Image size 640x480; acquired on the Clarity RetCam 3; wide-field fundus photograph from neonatal ROP screening.
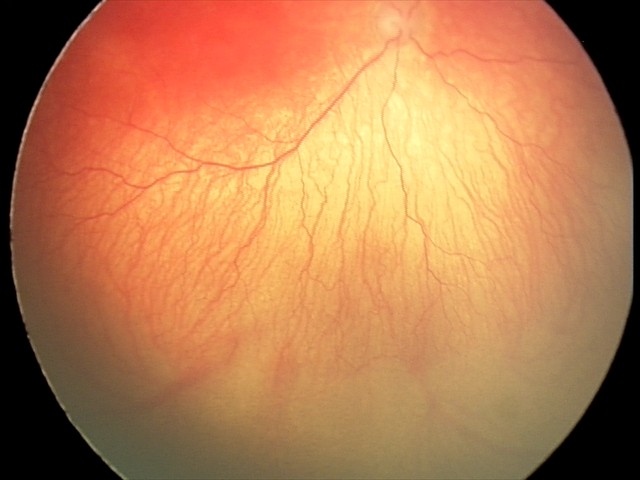

Finding = aggressive retinopathy of prematurity.